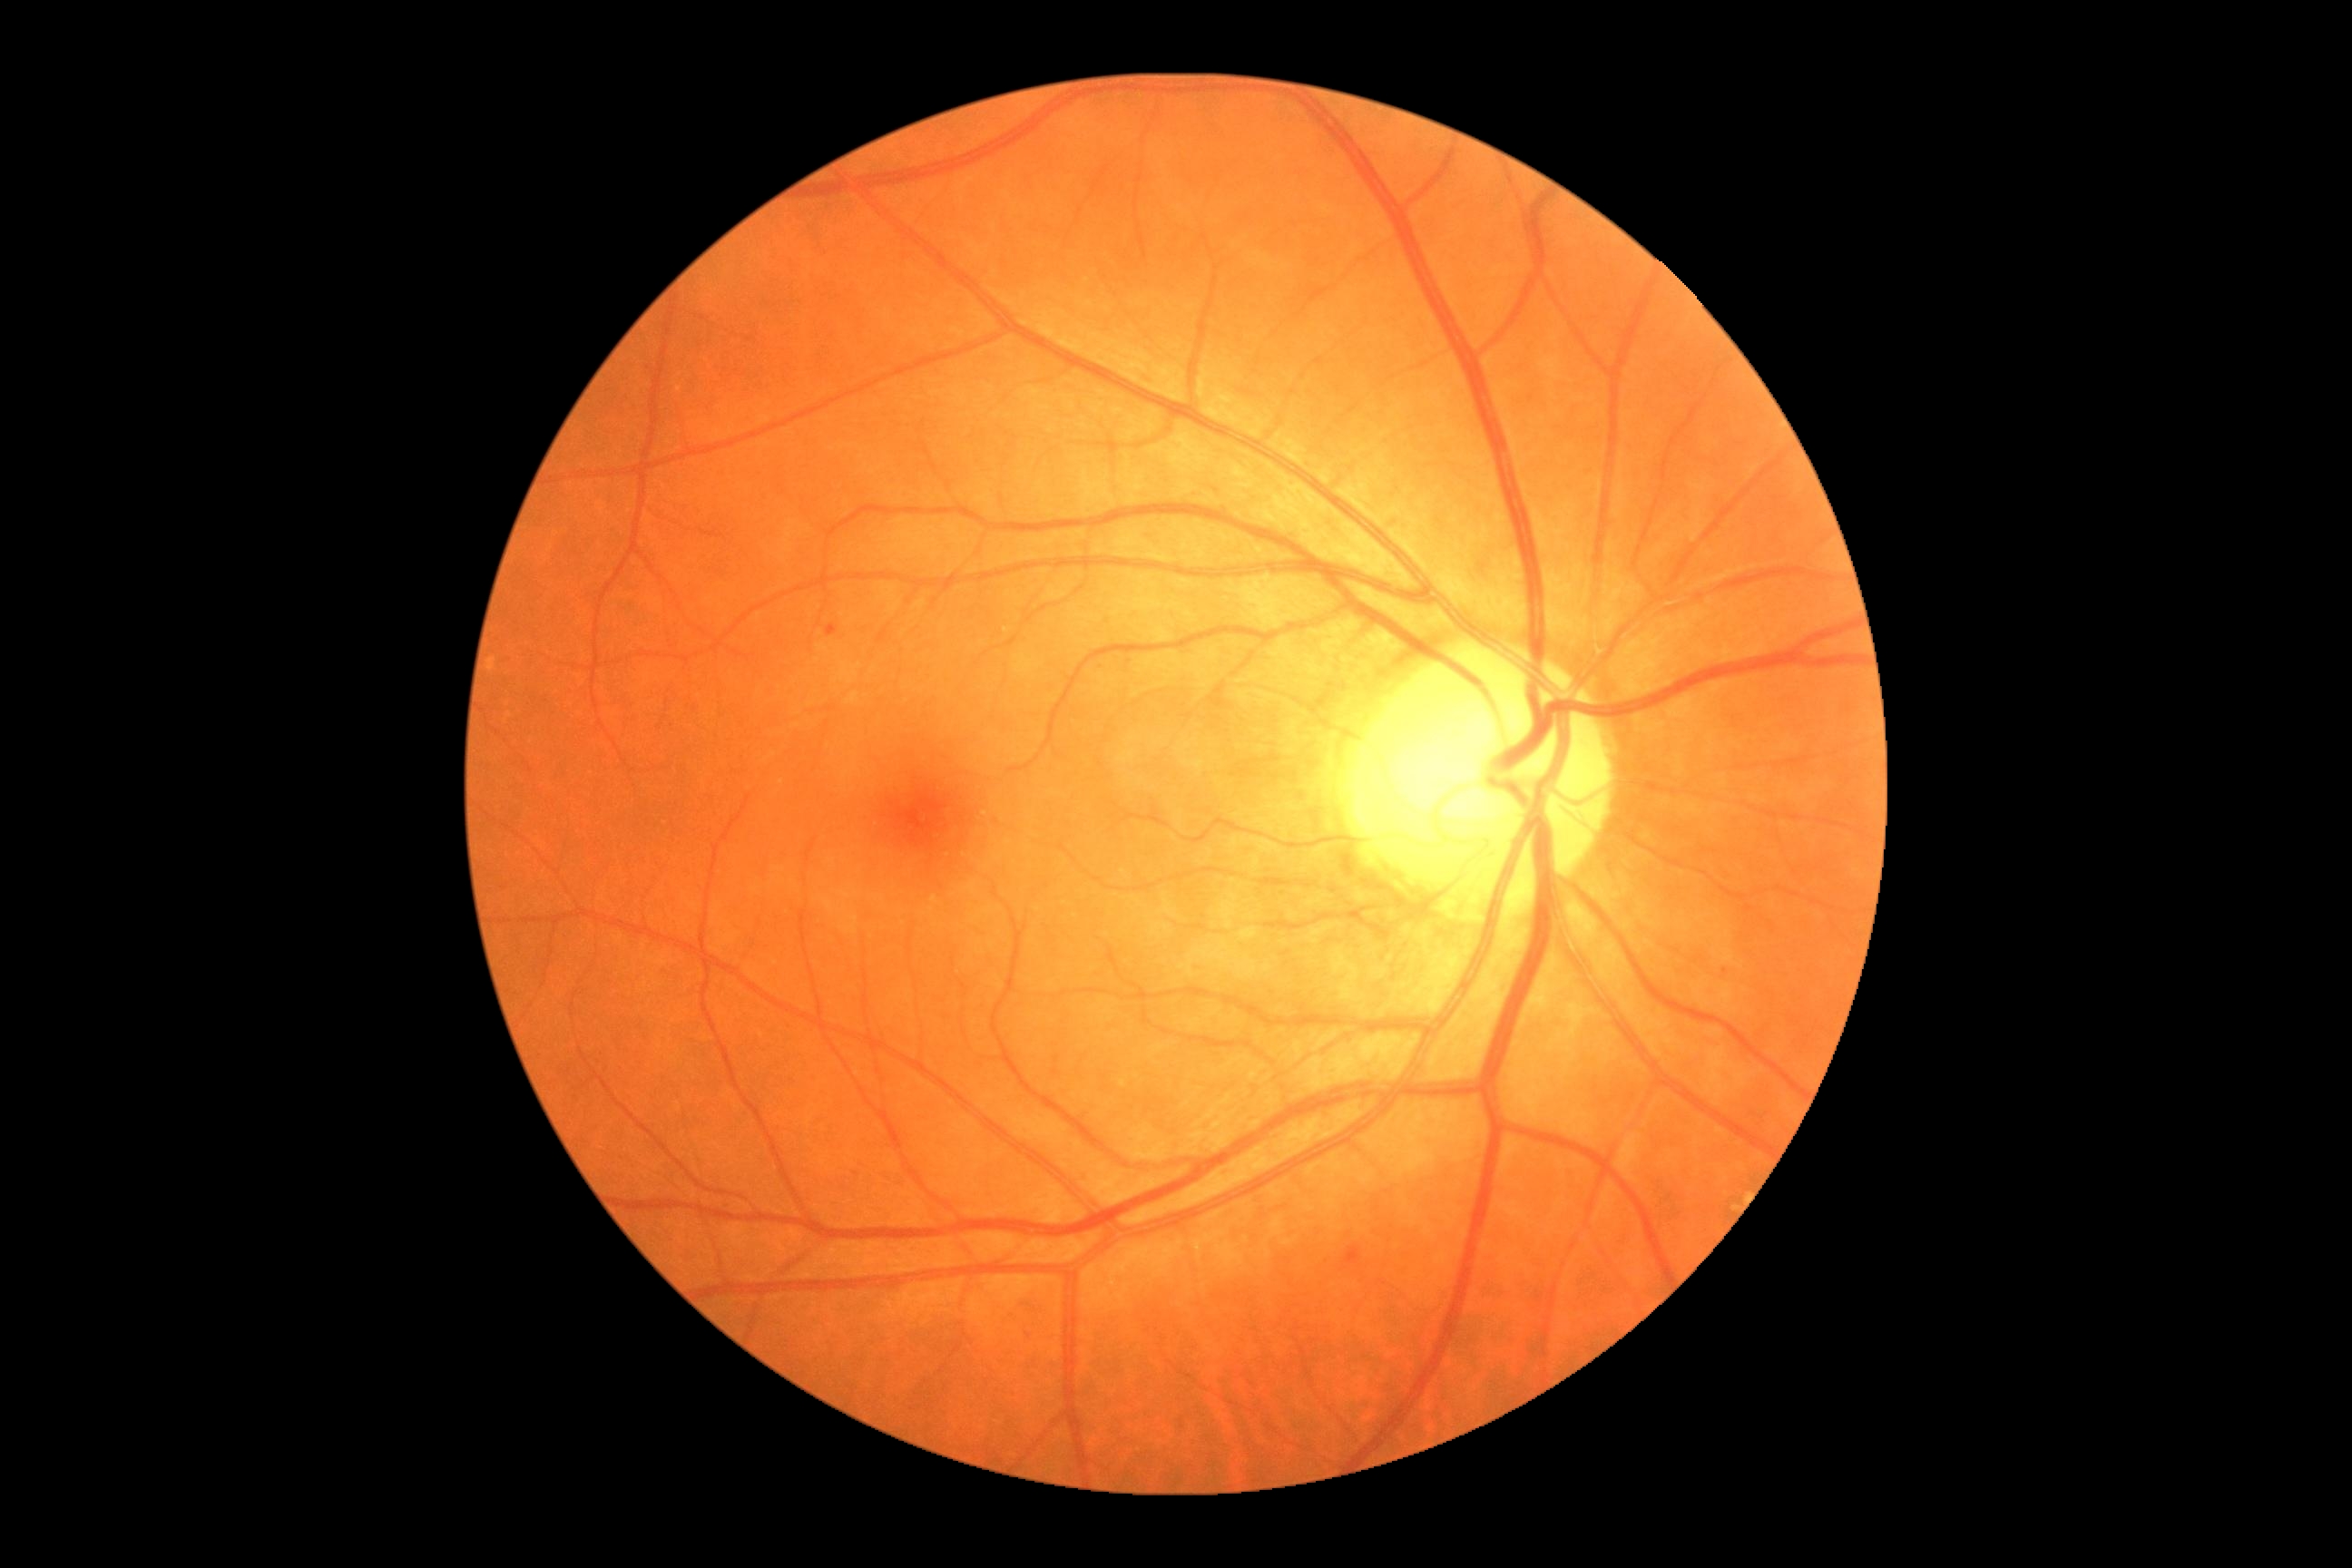 <lesions>
  <dr_grade>1</dr_grade>
  <se />
  <ma />
  <ex />
  <he>bbox(1344, 1246, 1362, 1269) | bbox(827, 625, 838, 638)</he>
</lesions>